Infant wide-field fundus photograph:
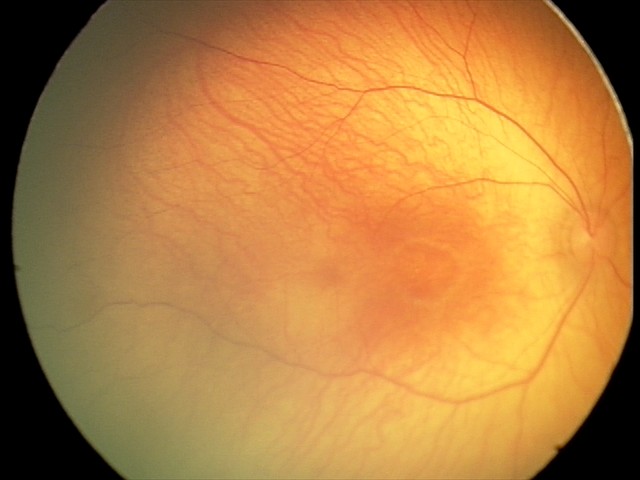
Series diagnosed as retinal hemorrhages.